Fundus photo
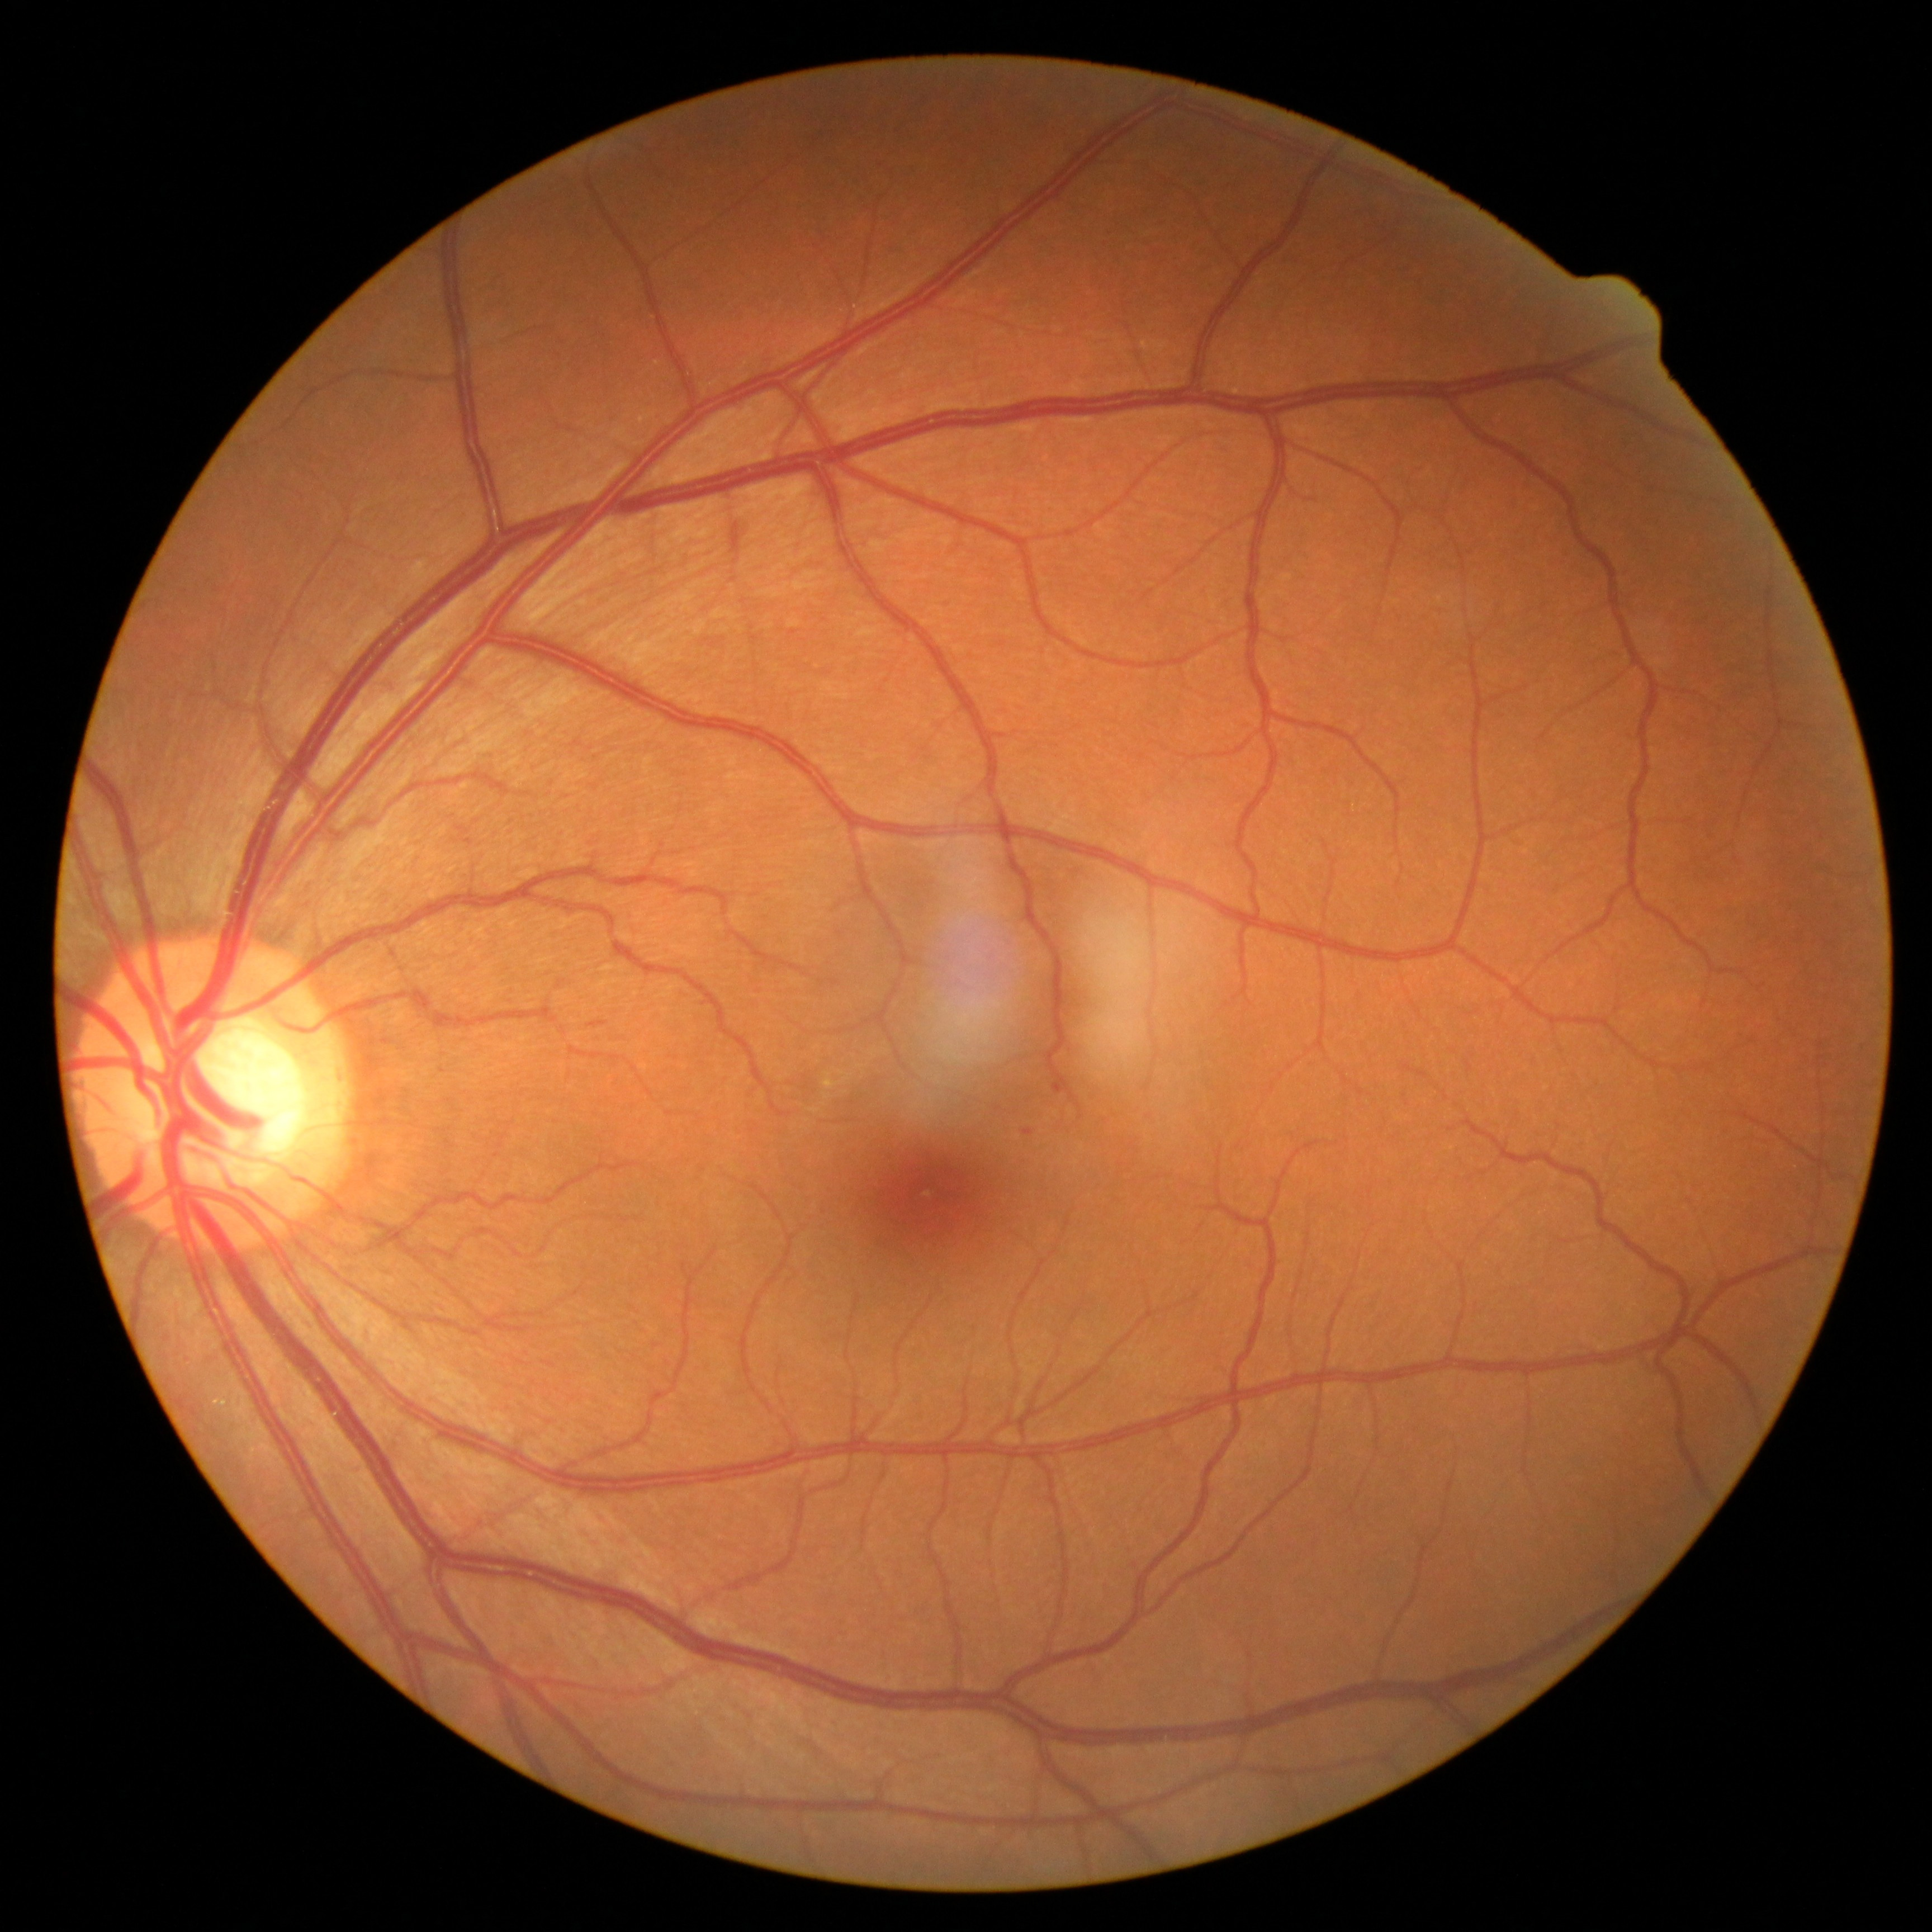

DR grade = 1.